848x848, 45° FOV
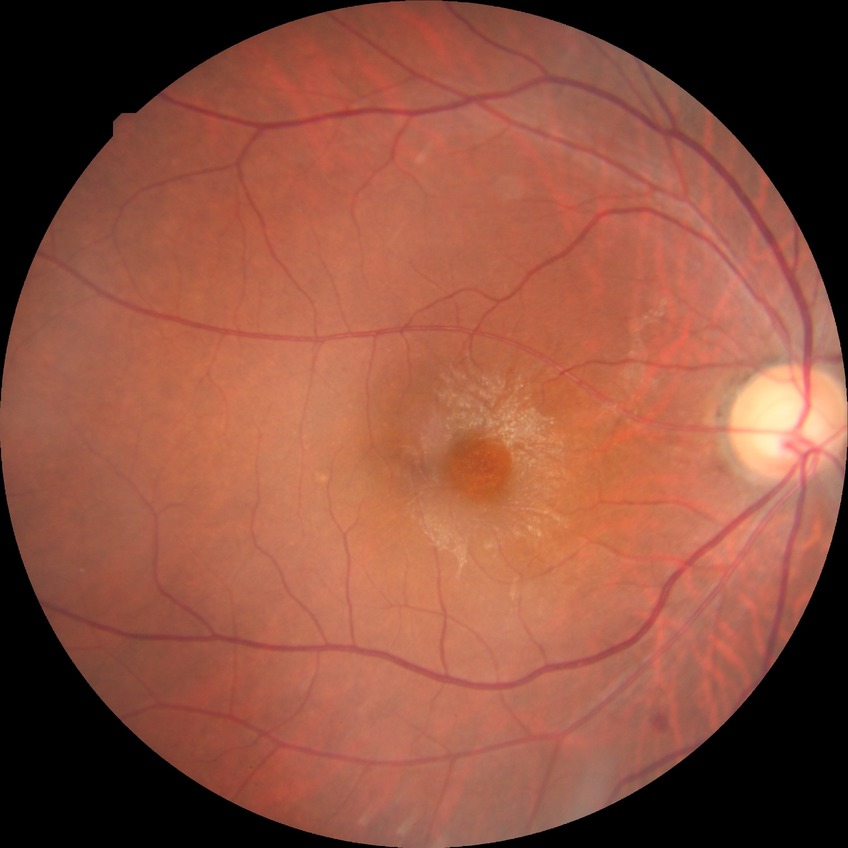

Davis grading=simple diabetic retinopathy.